2102x1736px. Retinal fundus photograph: 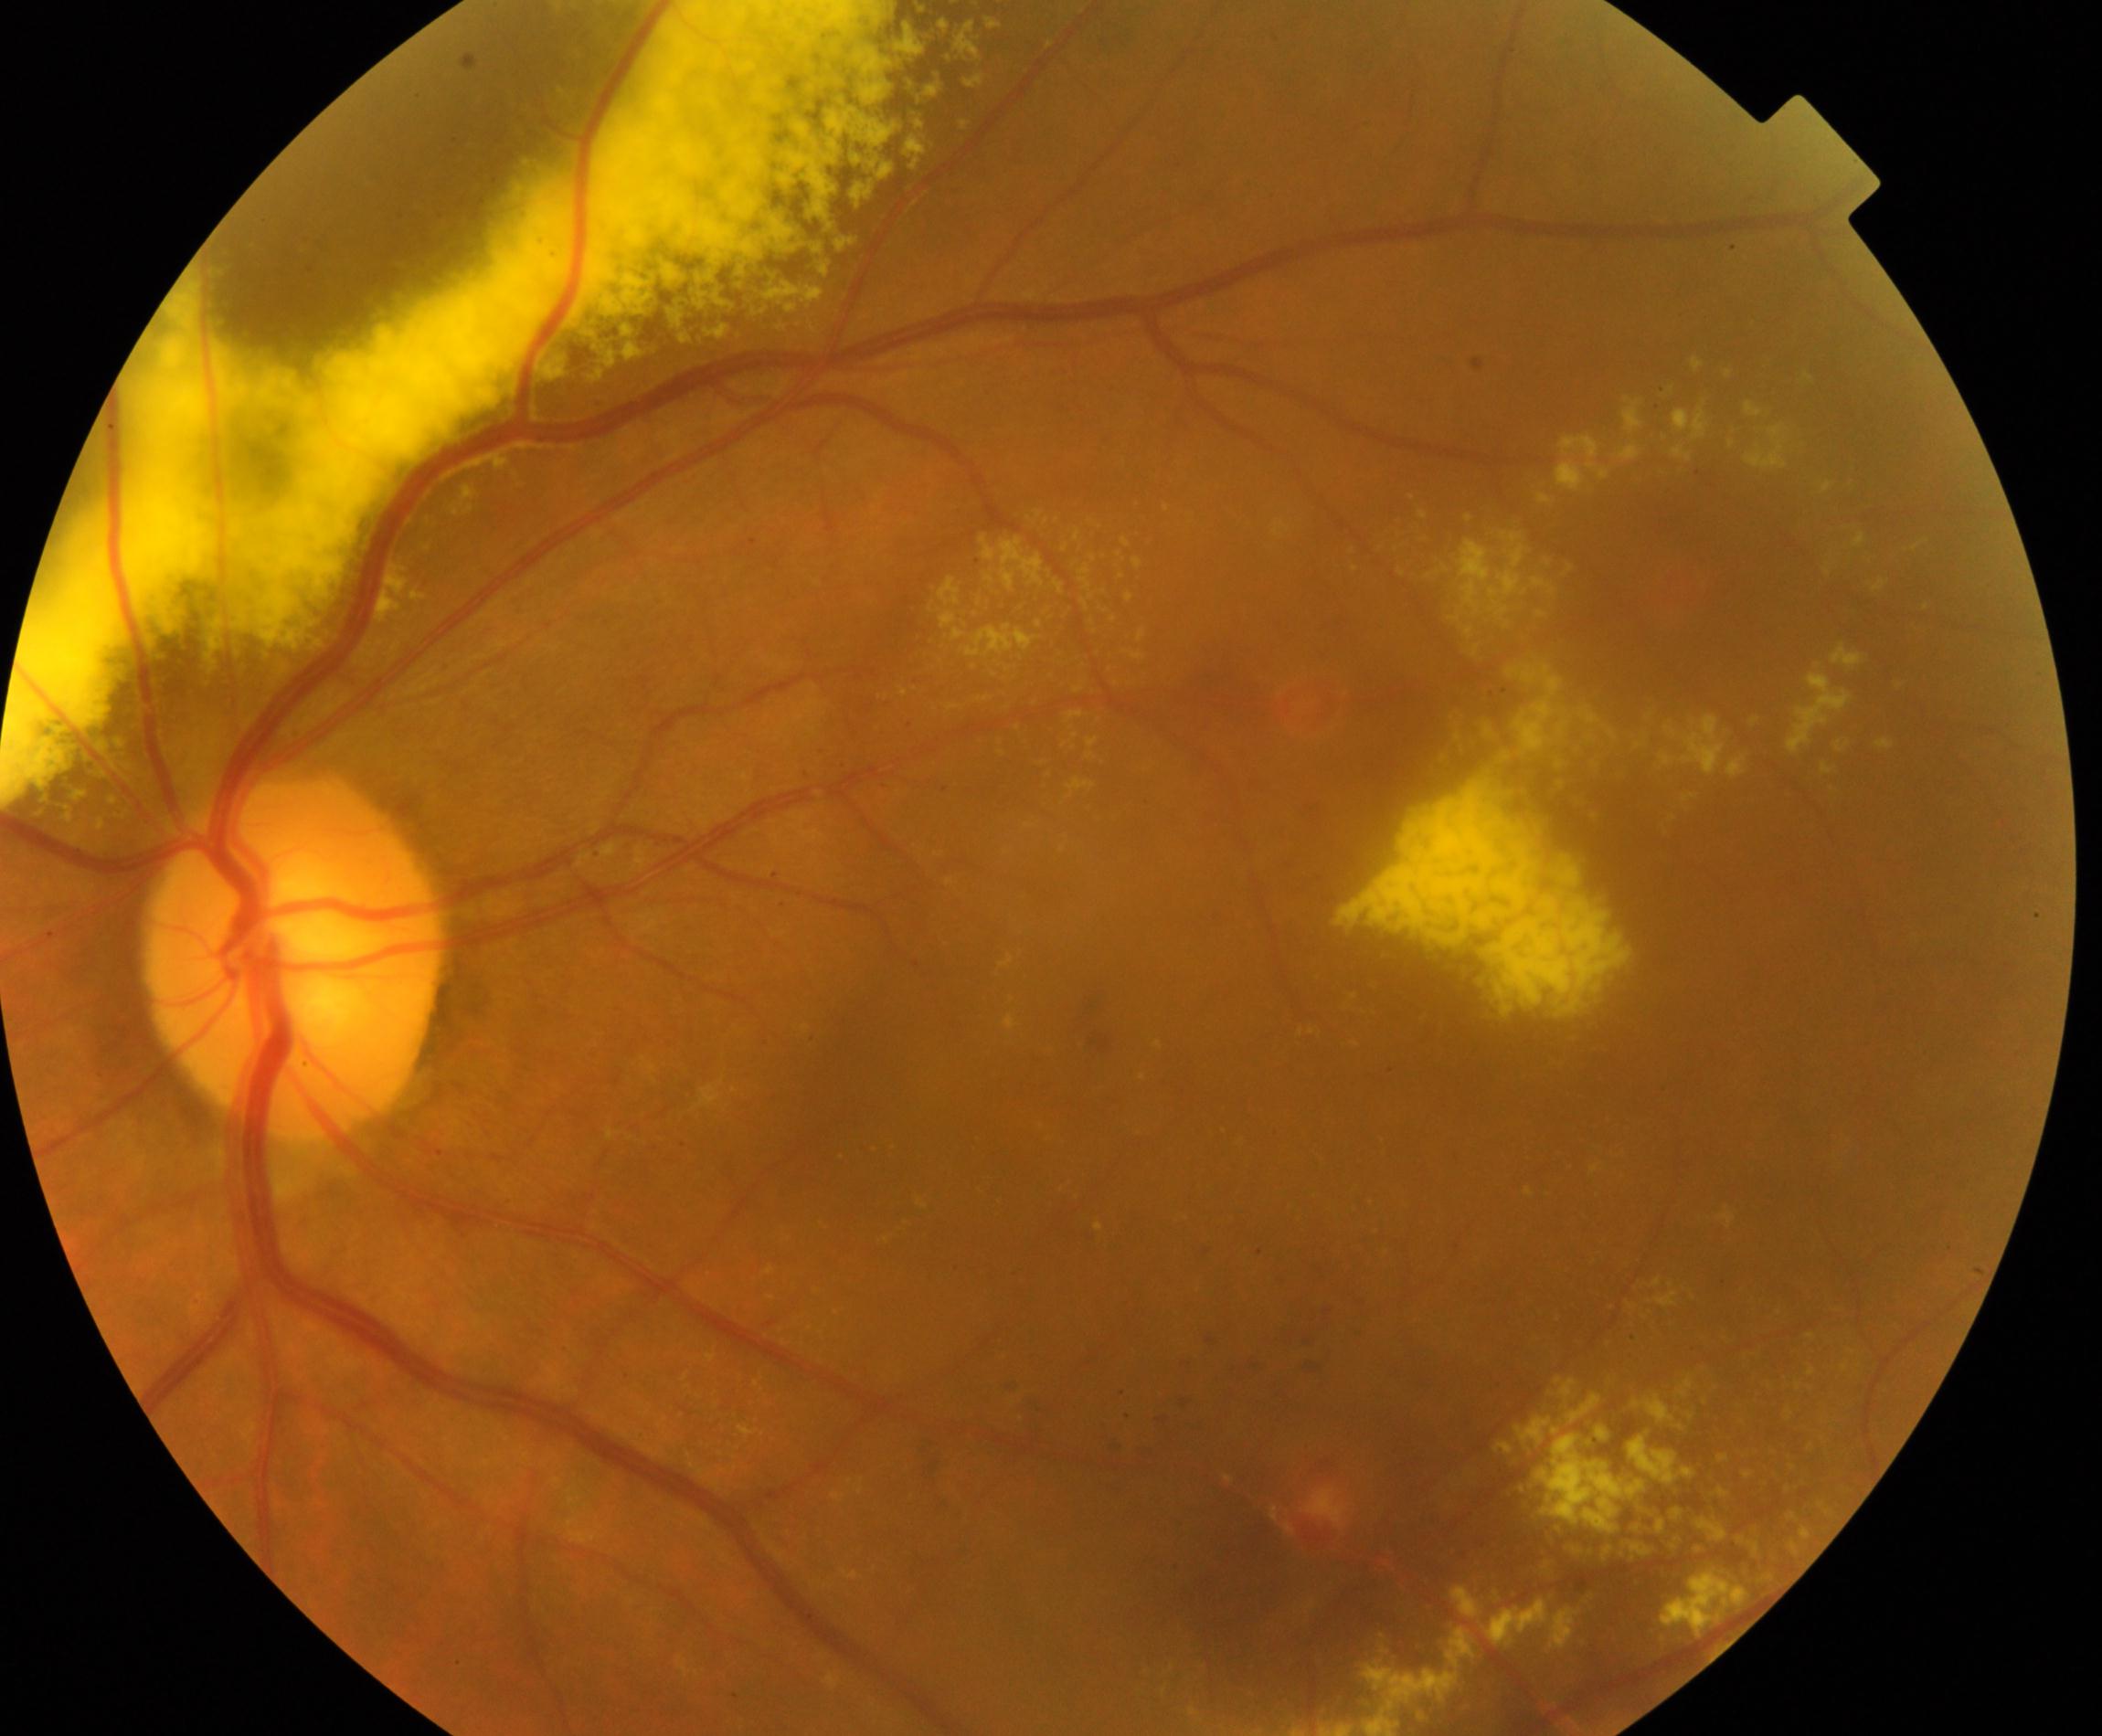 Diagnosis: massive hard exudates. Features include waxy yellow lesions with distinct margins arranged in large clumps, usually caused by vascular abnormalities.